848 x 848 pixels · NIDEK AFC-230 — 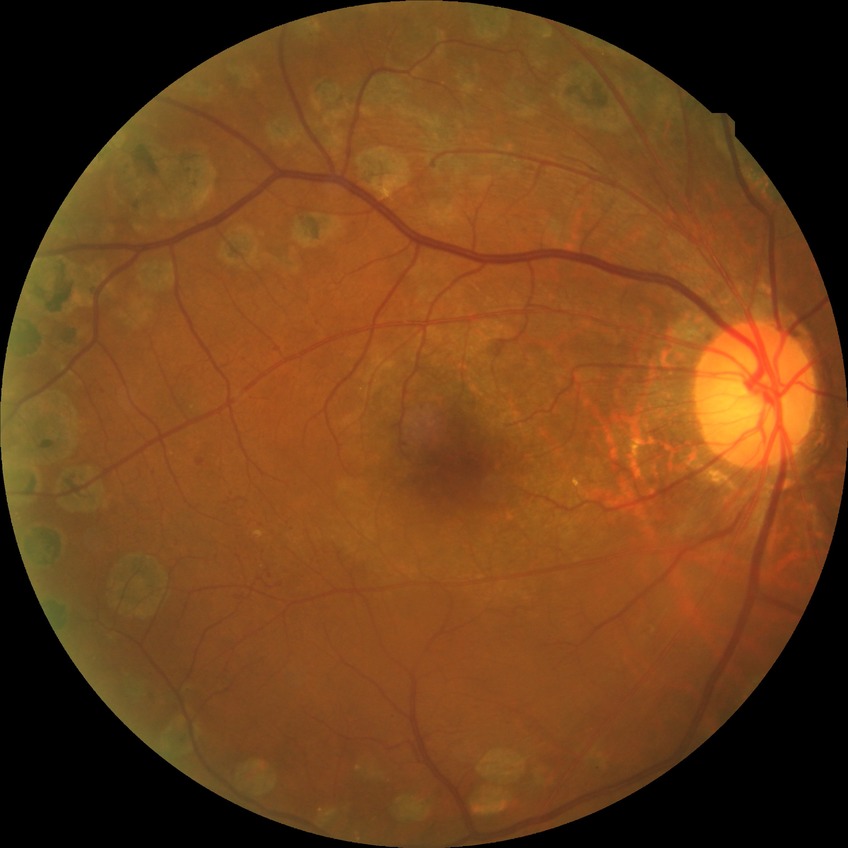

Diabetic retinopathy (DR): proliferative diabetic retinopathy (PDR).